Color fundus photograph · 45-degree field of view
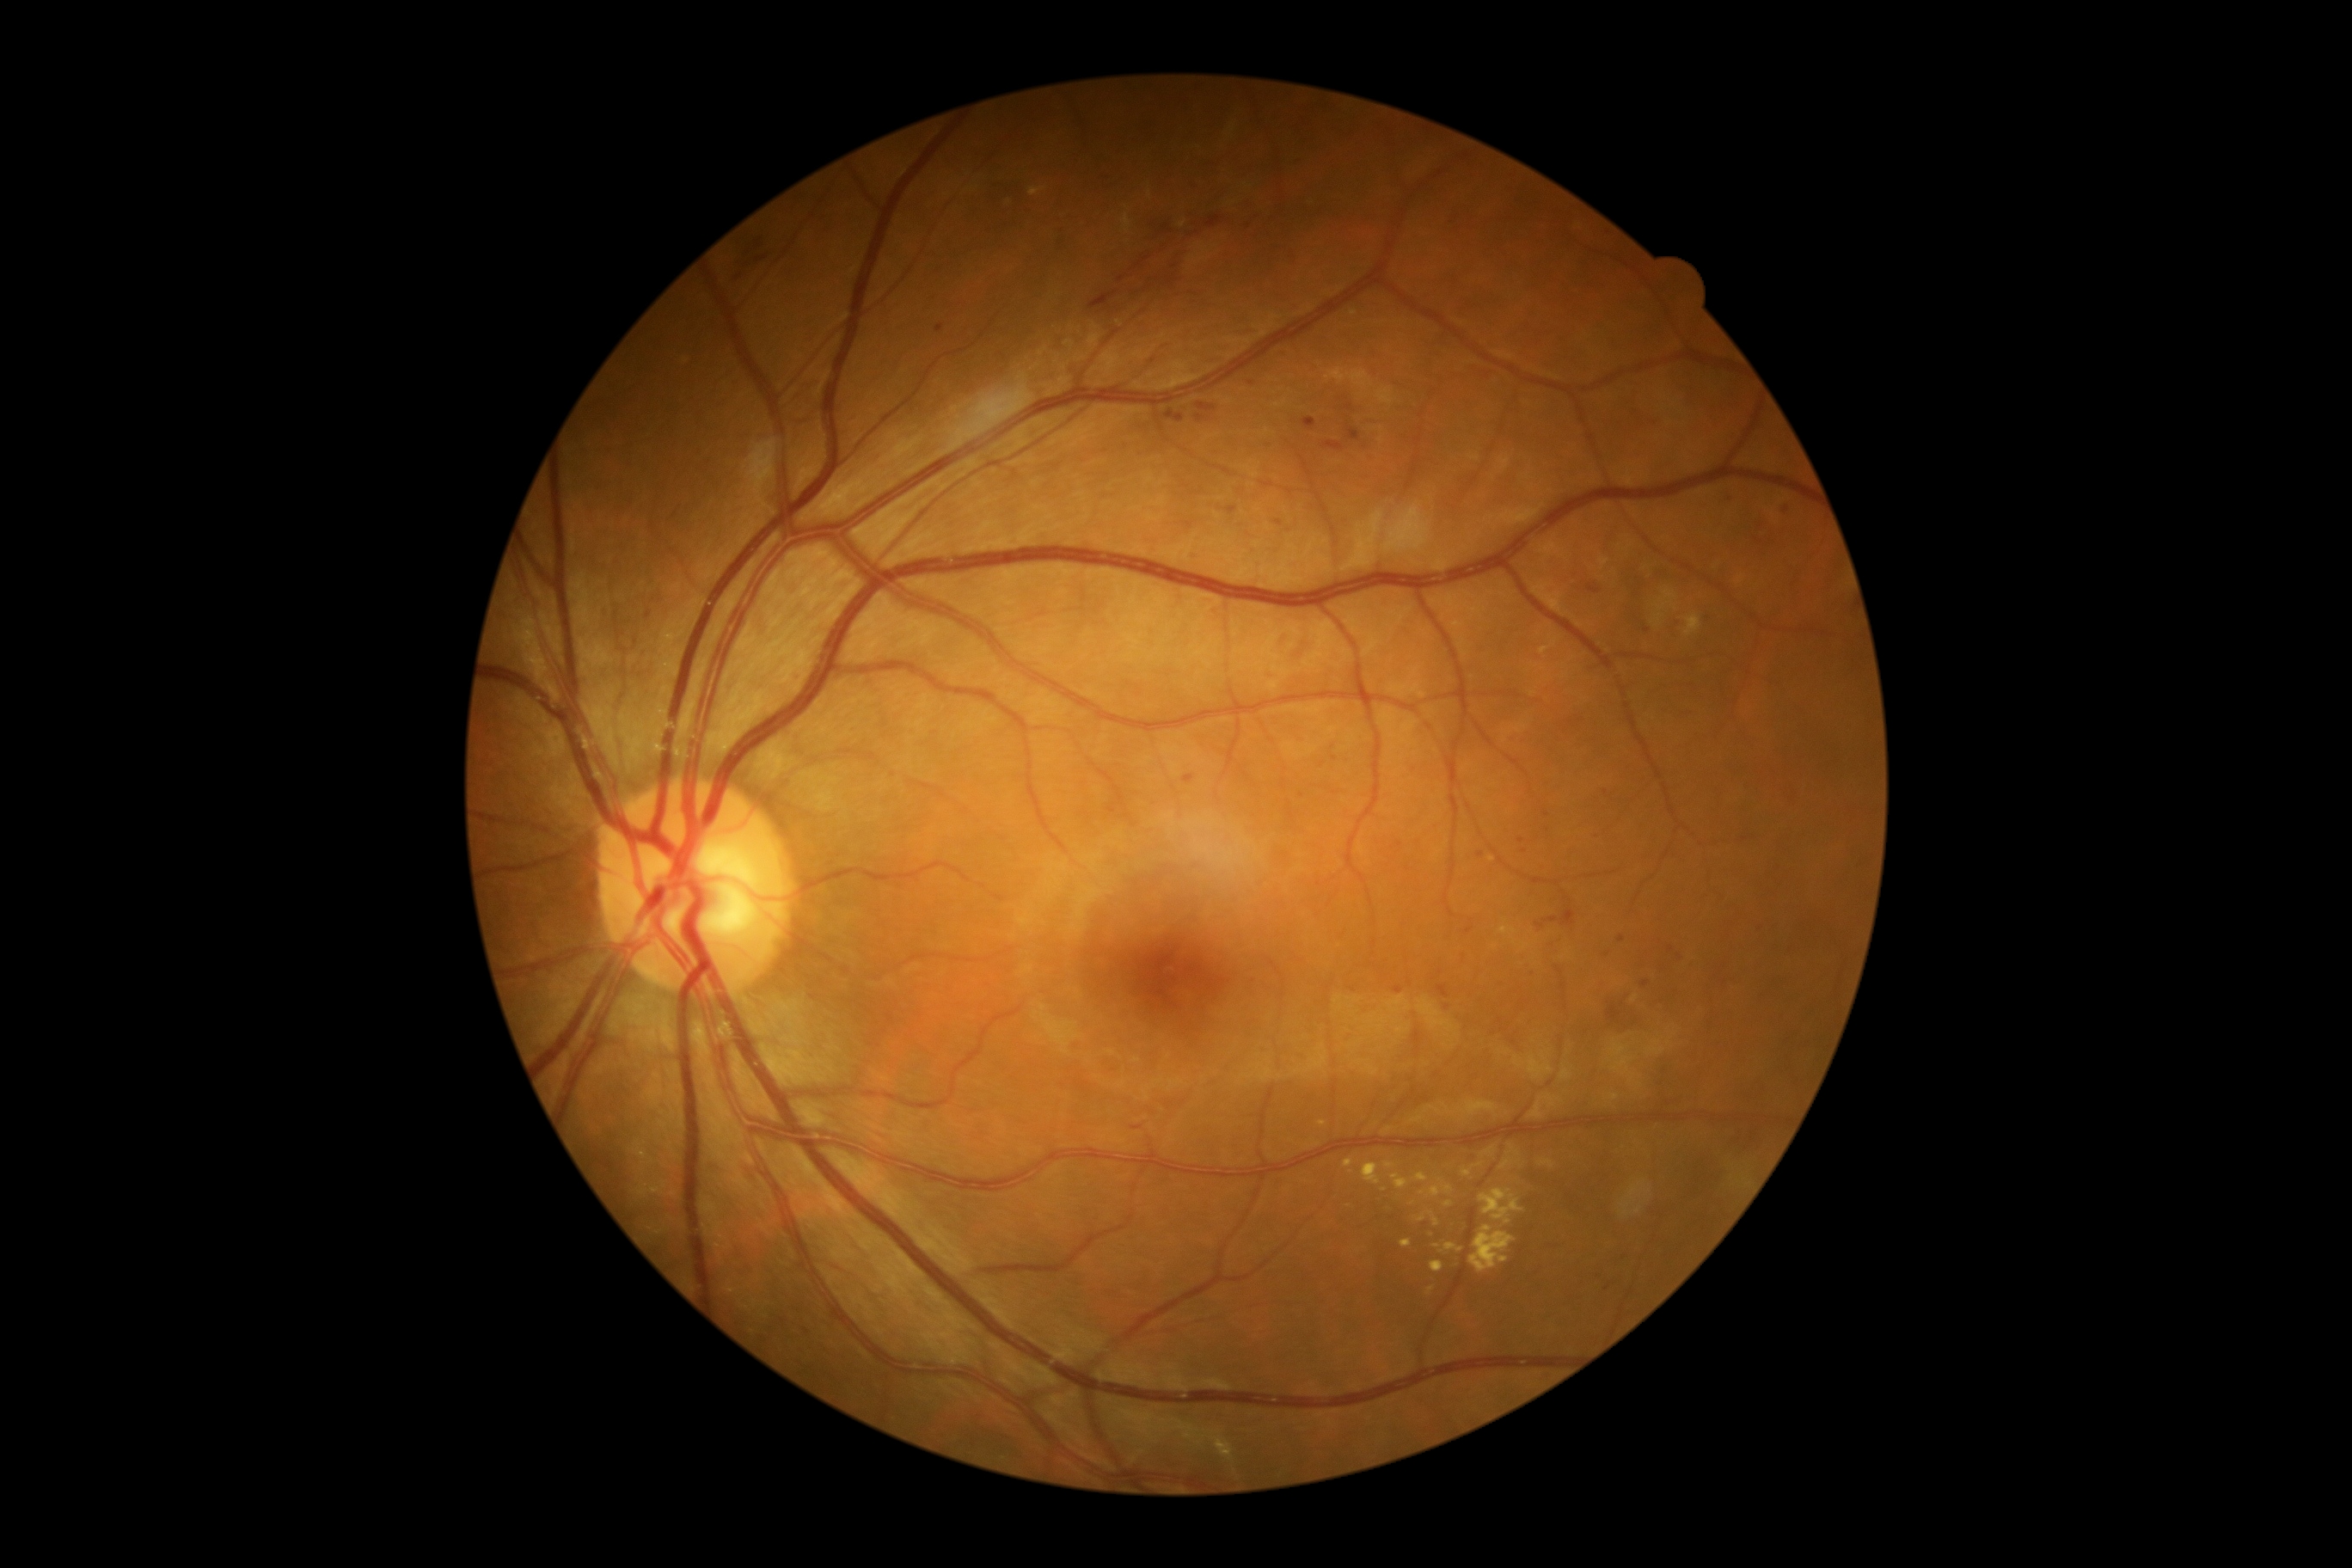

<lesions partial="true">
  <dr_grade>2</dr_grade>
  <ex partial="true">rect(1479, 1189, 1524, 1225); rect(1684, 613, 1703, 637); rect(1031, 188, 1046, 197); rect(1390, 1173, 1411, 1189); rect(1440, 1244, 1464, 1254); rect(1344, 1160, 1354, 1168); rect(1443, 1185, 1454, 1196); rect(1433, 1216, 1442, 1227); rect(1481, 1146, 1497, 1158)</ex>
  <ex_small>Point(1422, 1219); Point(1413, 1204); Point(1384, 1189)</ex_small>
  <ma partial="true">rect(1393, 986, 1404, 995); rect(1302, 419, 1316, 431); rect(1323, 443, 1345, 451); rect(1275, 520, 1283, 527); rect(1225, 506, 1237, 515); rect(1607, 1005, 1622, 1024); rect(1184, 524, 1194, 530)</ma>
  <ma_small>Point(1330, 987); Point(1353, 990); Point(1441, 973); Point(1524, 852); Point(1670, 949); Point(1546, 814); Point(1607, 955); Point(1787, 509); Point(1647, 631)</ma_small>
</lesions>